Camera: Topcon TRC-NW8 · mydriatic (tropicamide phenylephrine 1.0%) · macula at the center of the field.
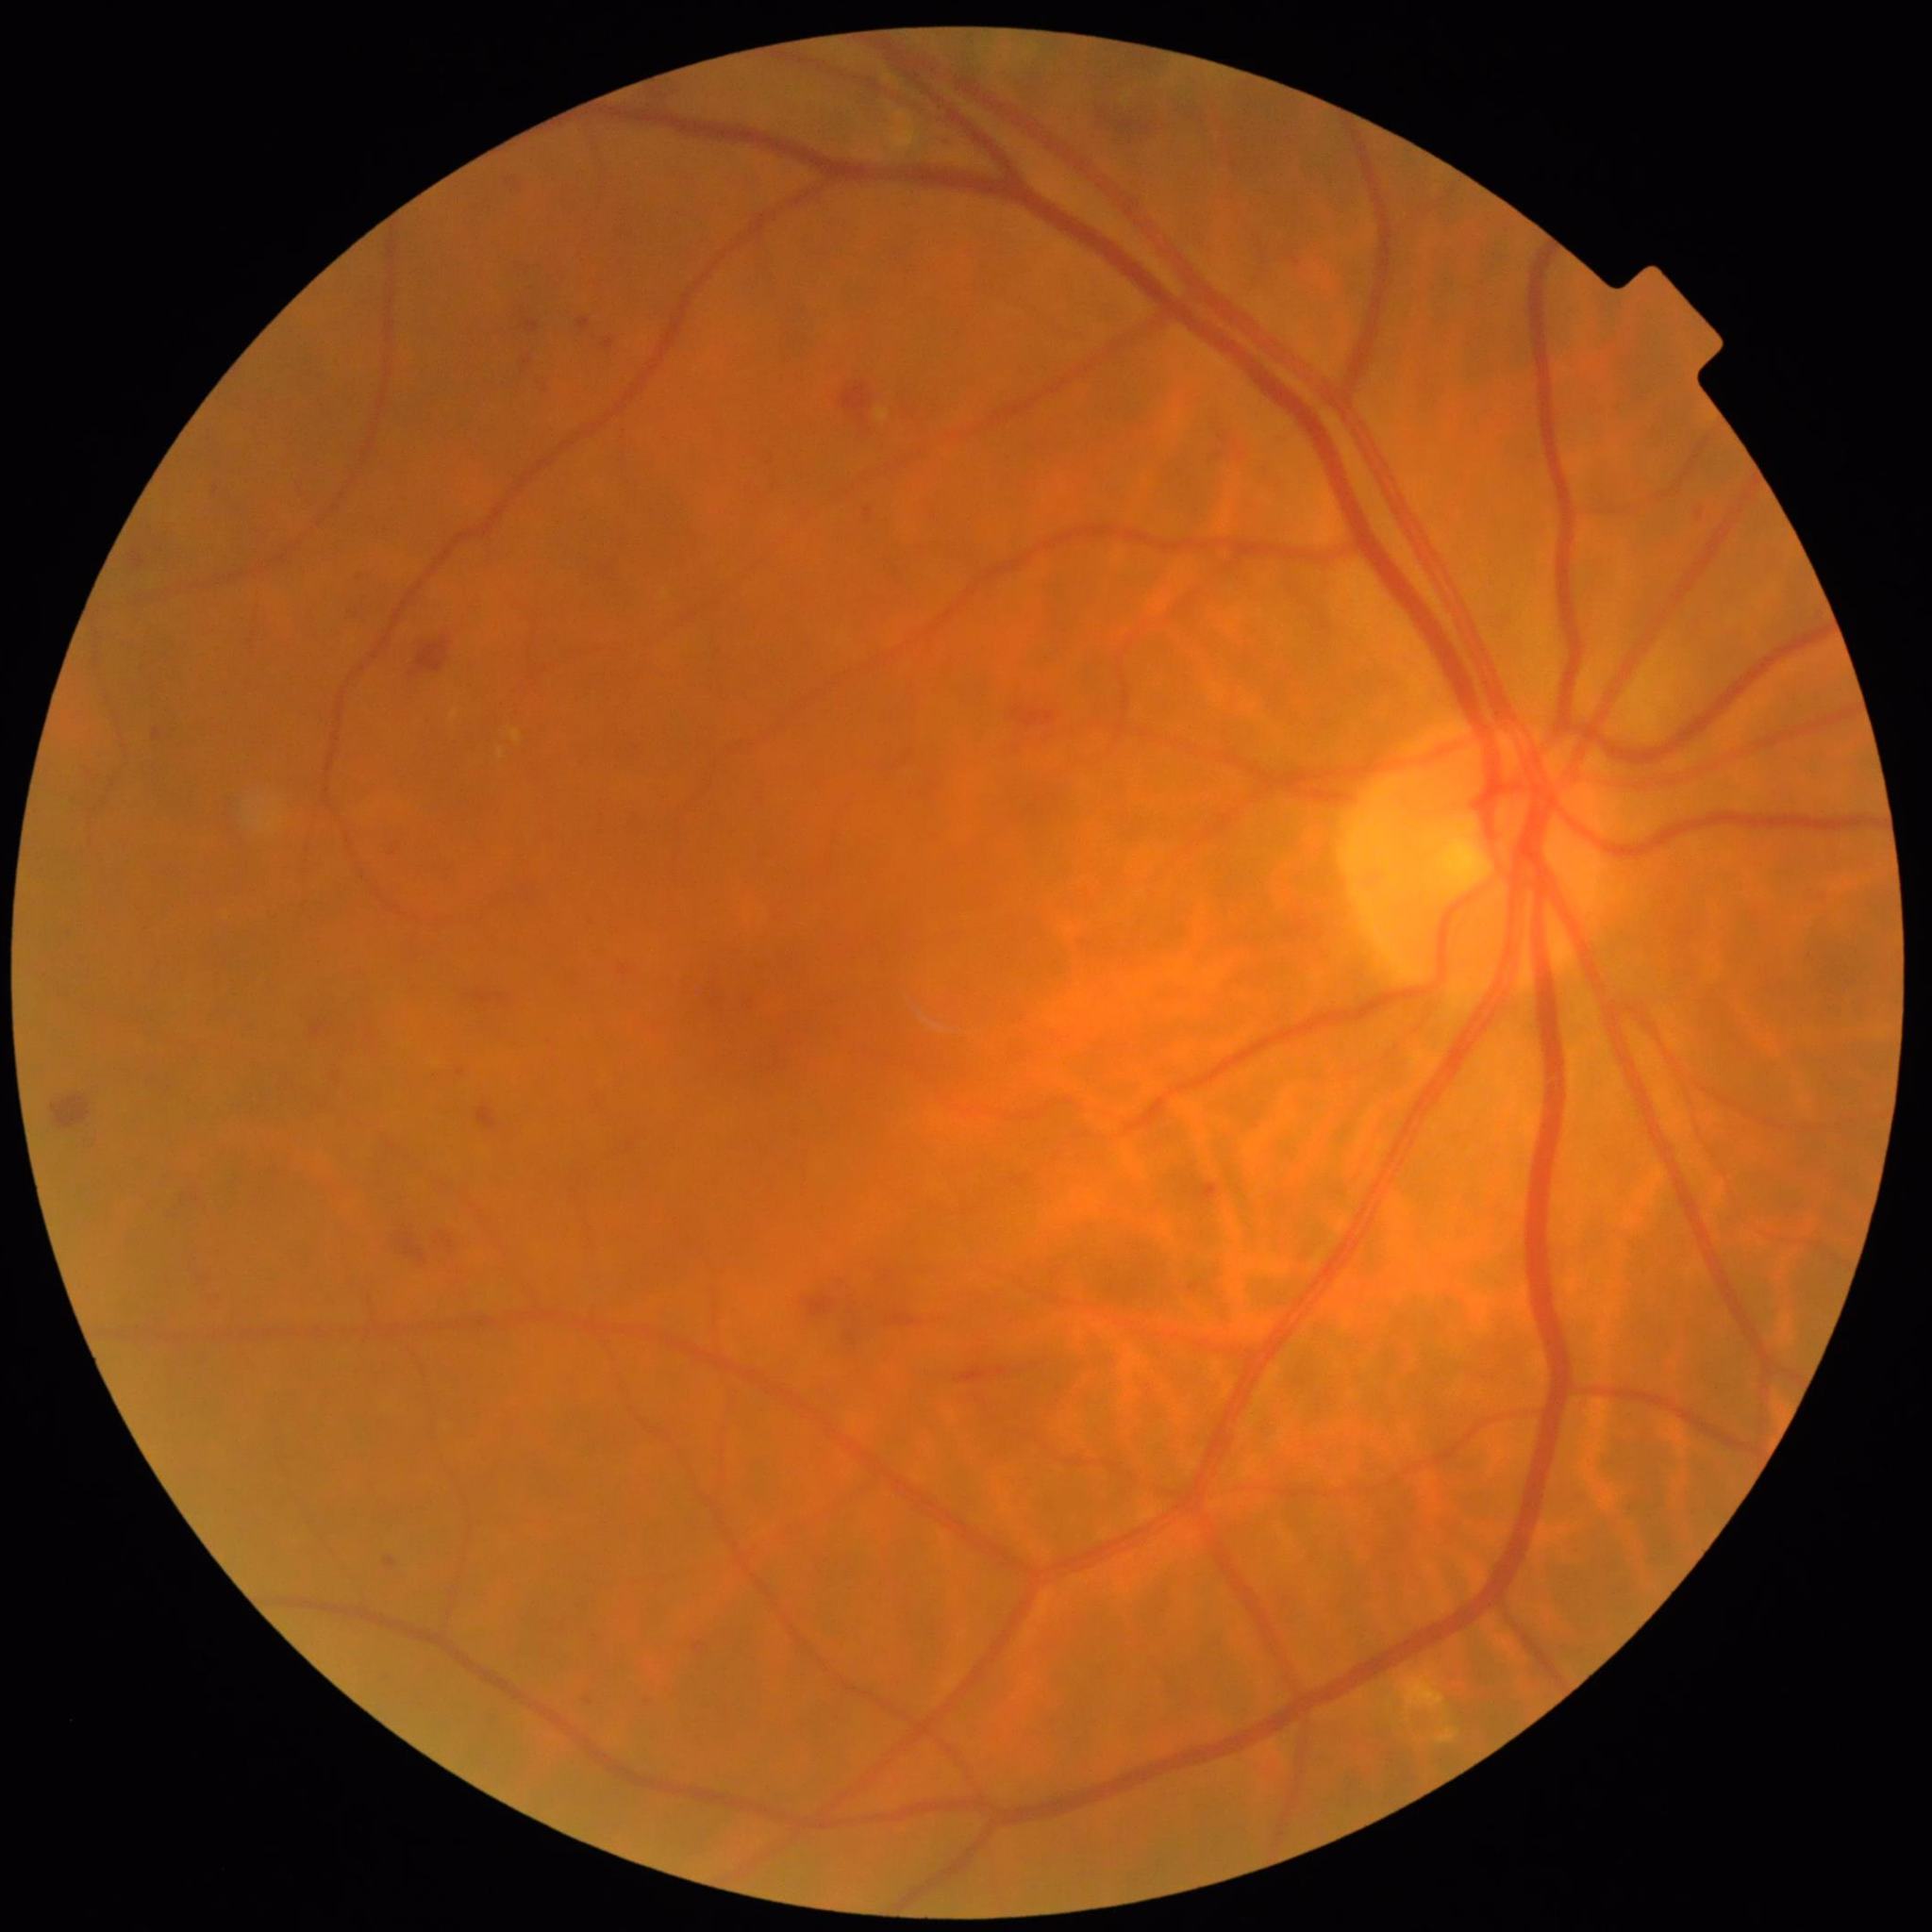

Eye affected by diabetic retinopathy. Image quality: no concerns identified.